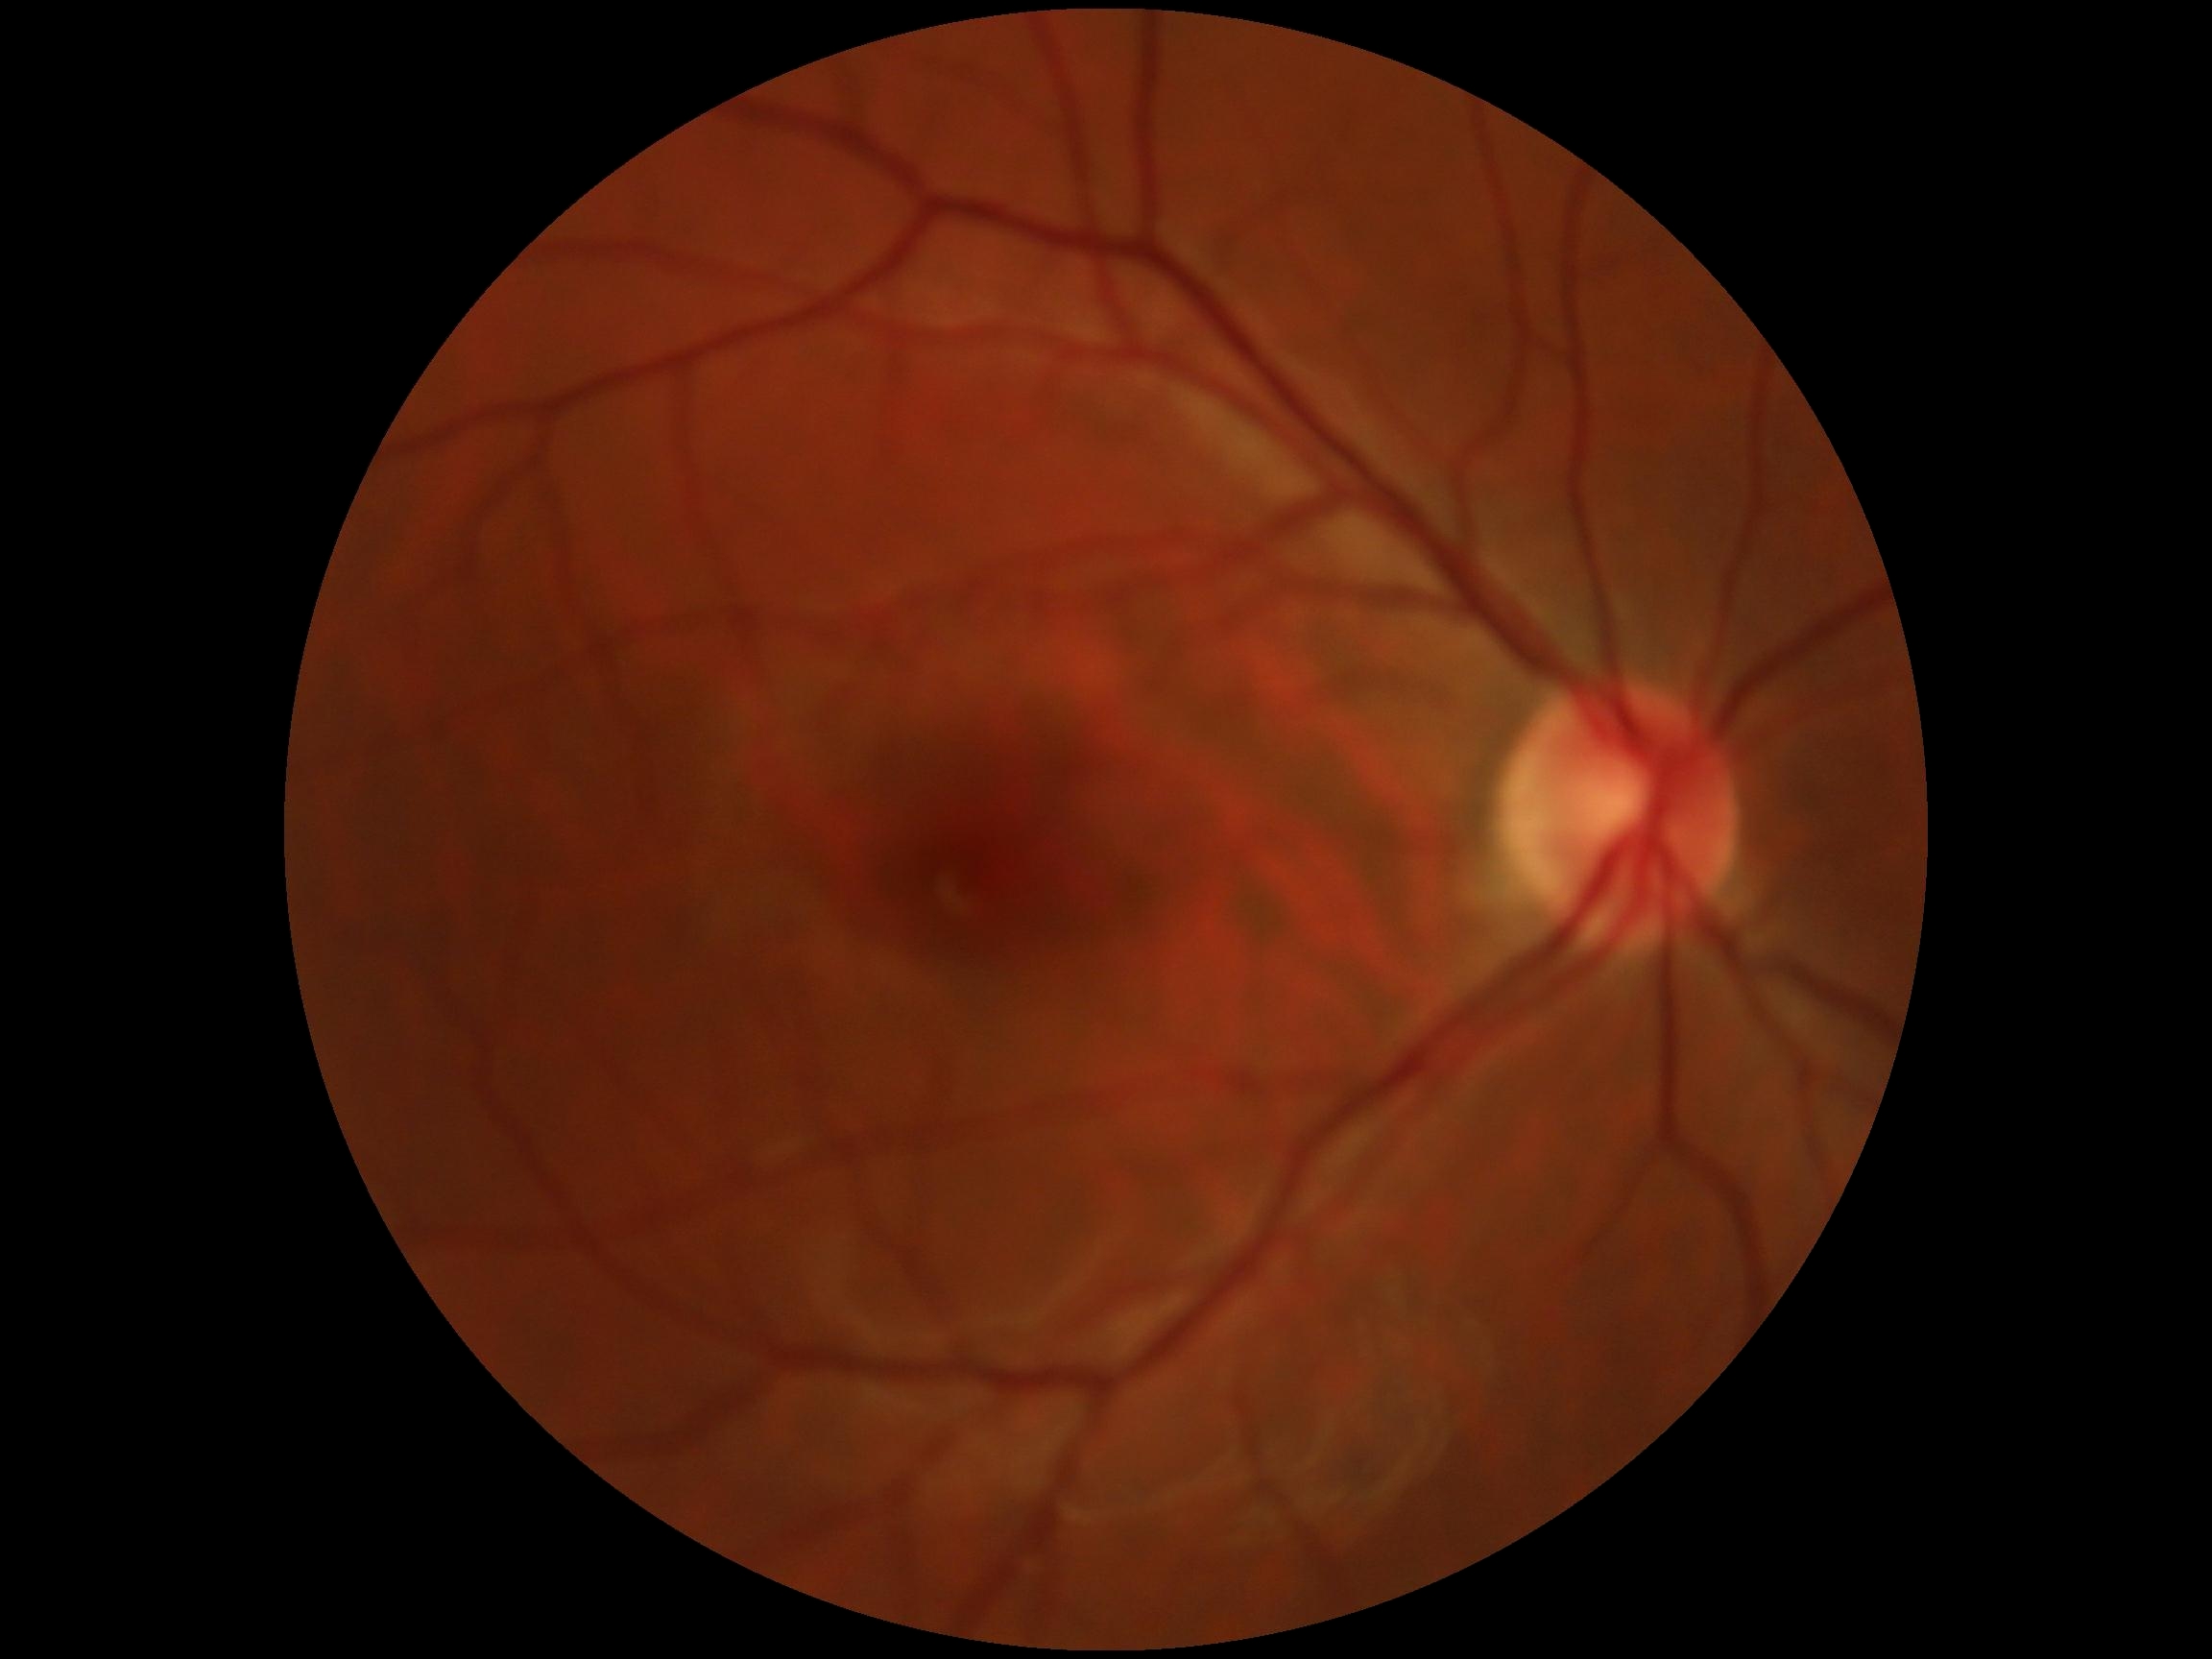

DR severity is grade 0 (no apparent retinopathy) — no visible signs of diabetic retinopathy.